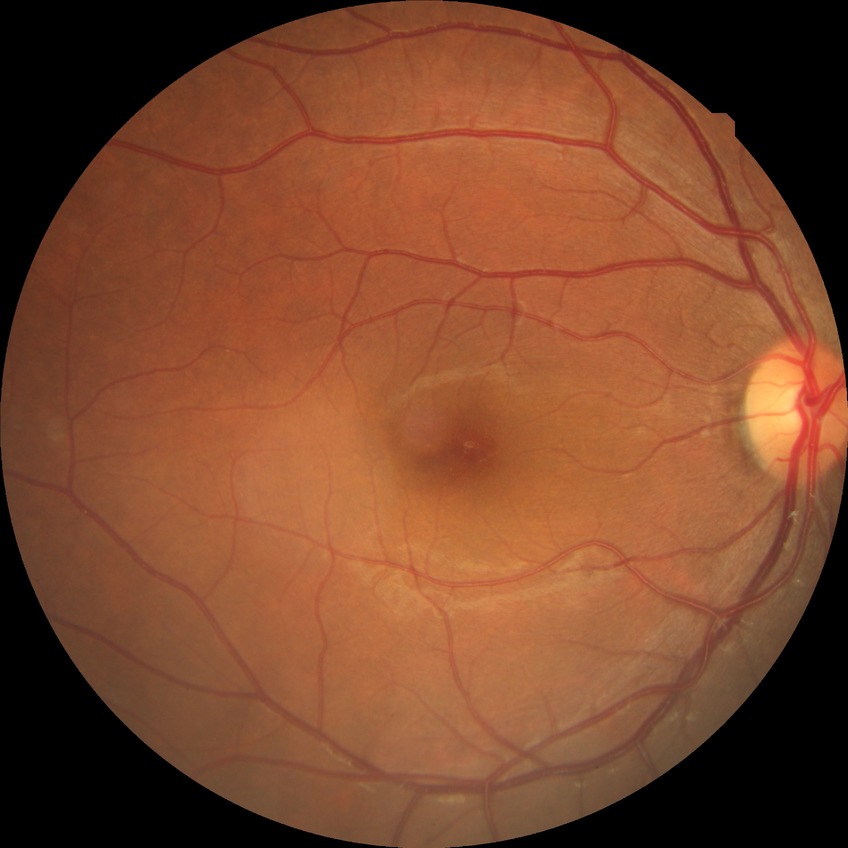 Diabetic retinopathy grade: no diabetic retinopathy.